Modified Davis classification — 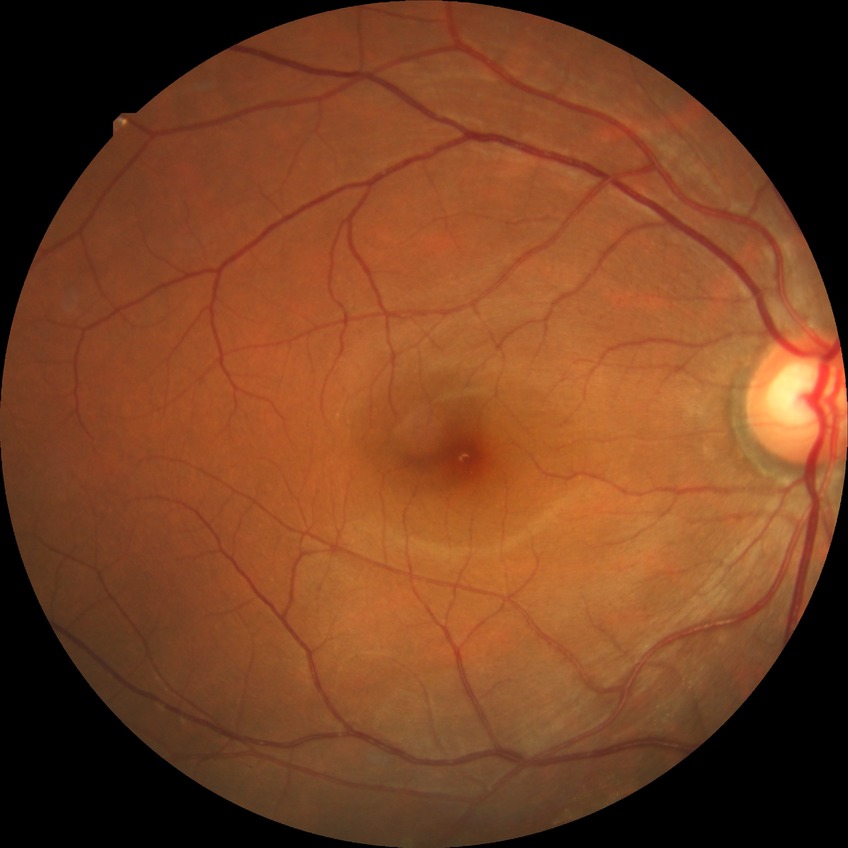

Diabetic retinopathy (DR): SDR (simple diabetic retinopathy).